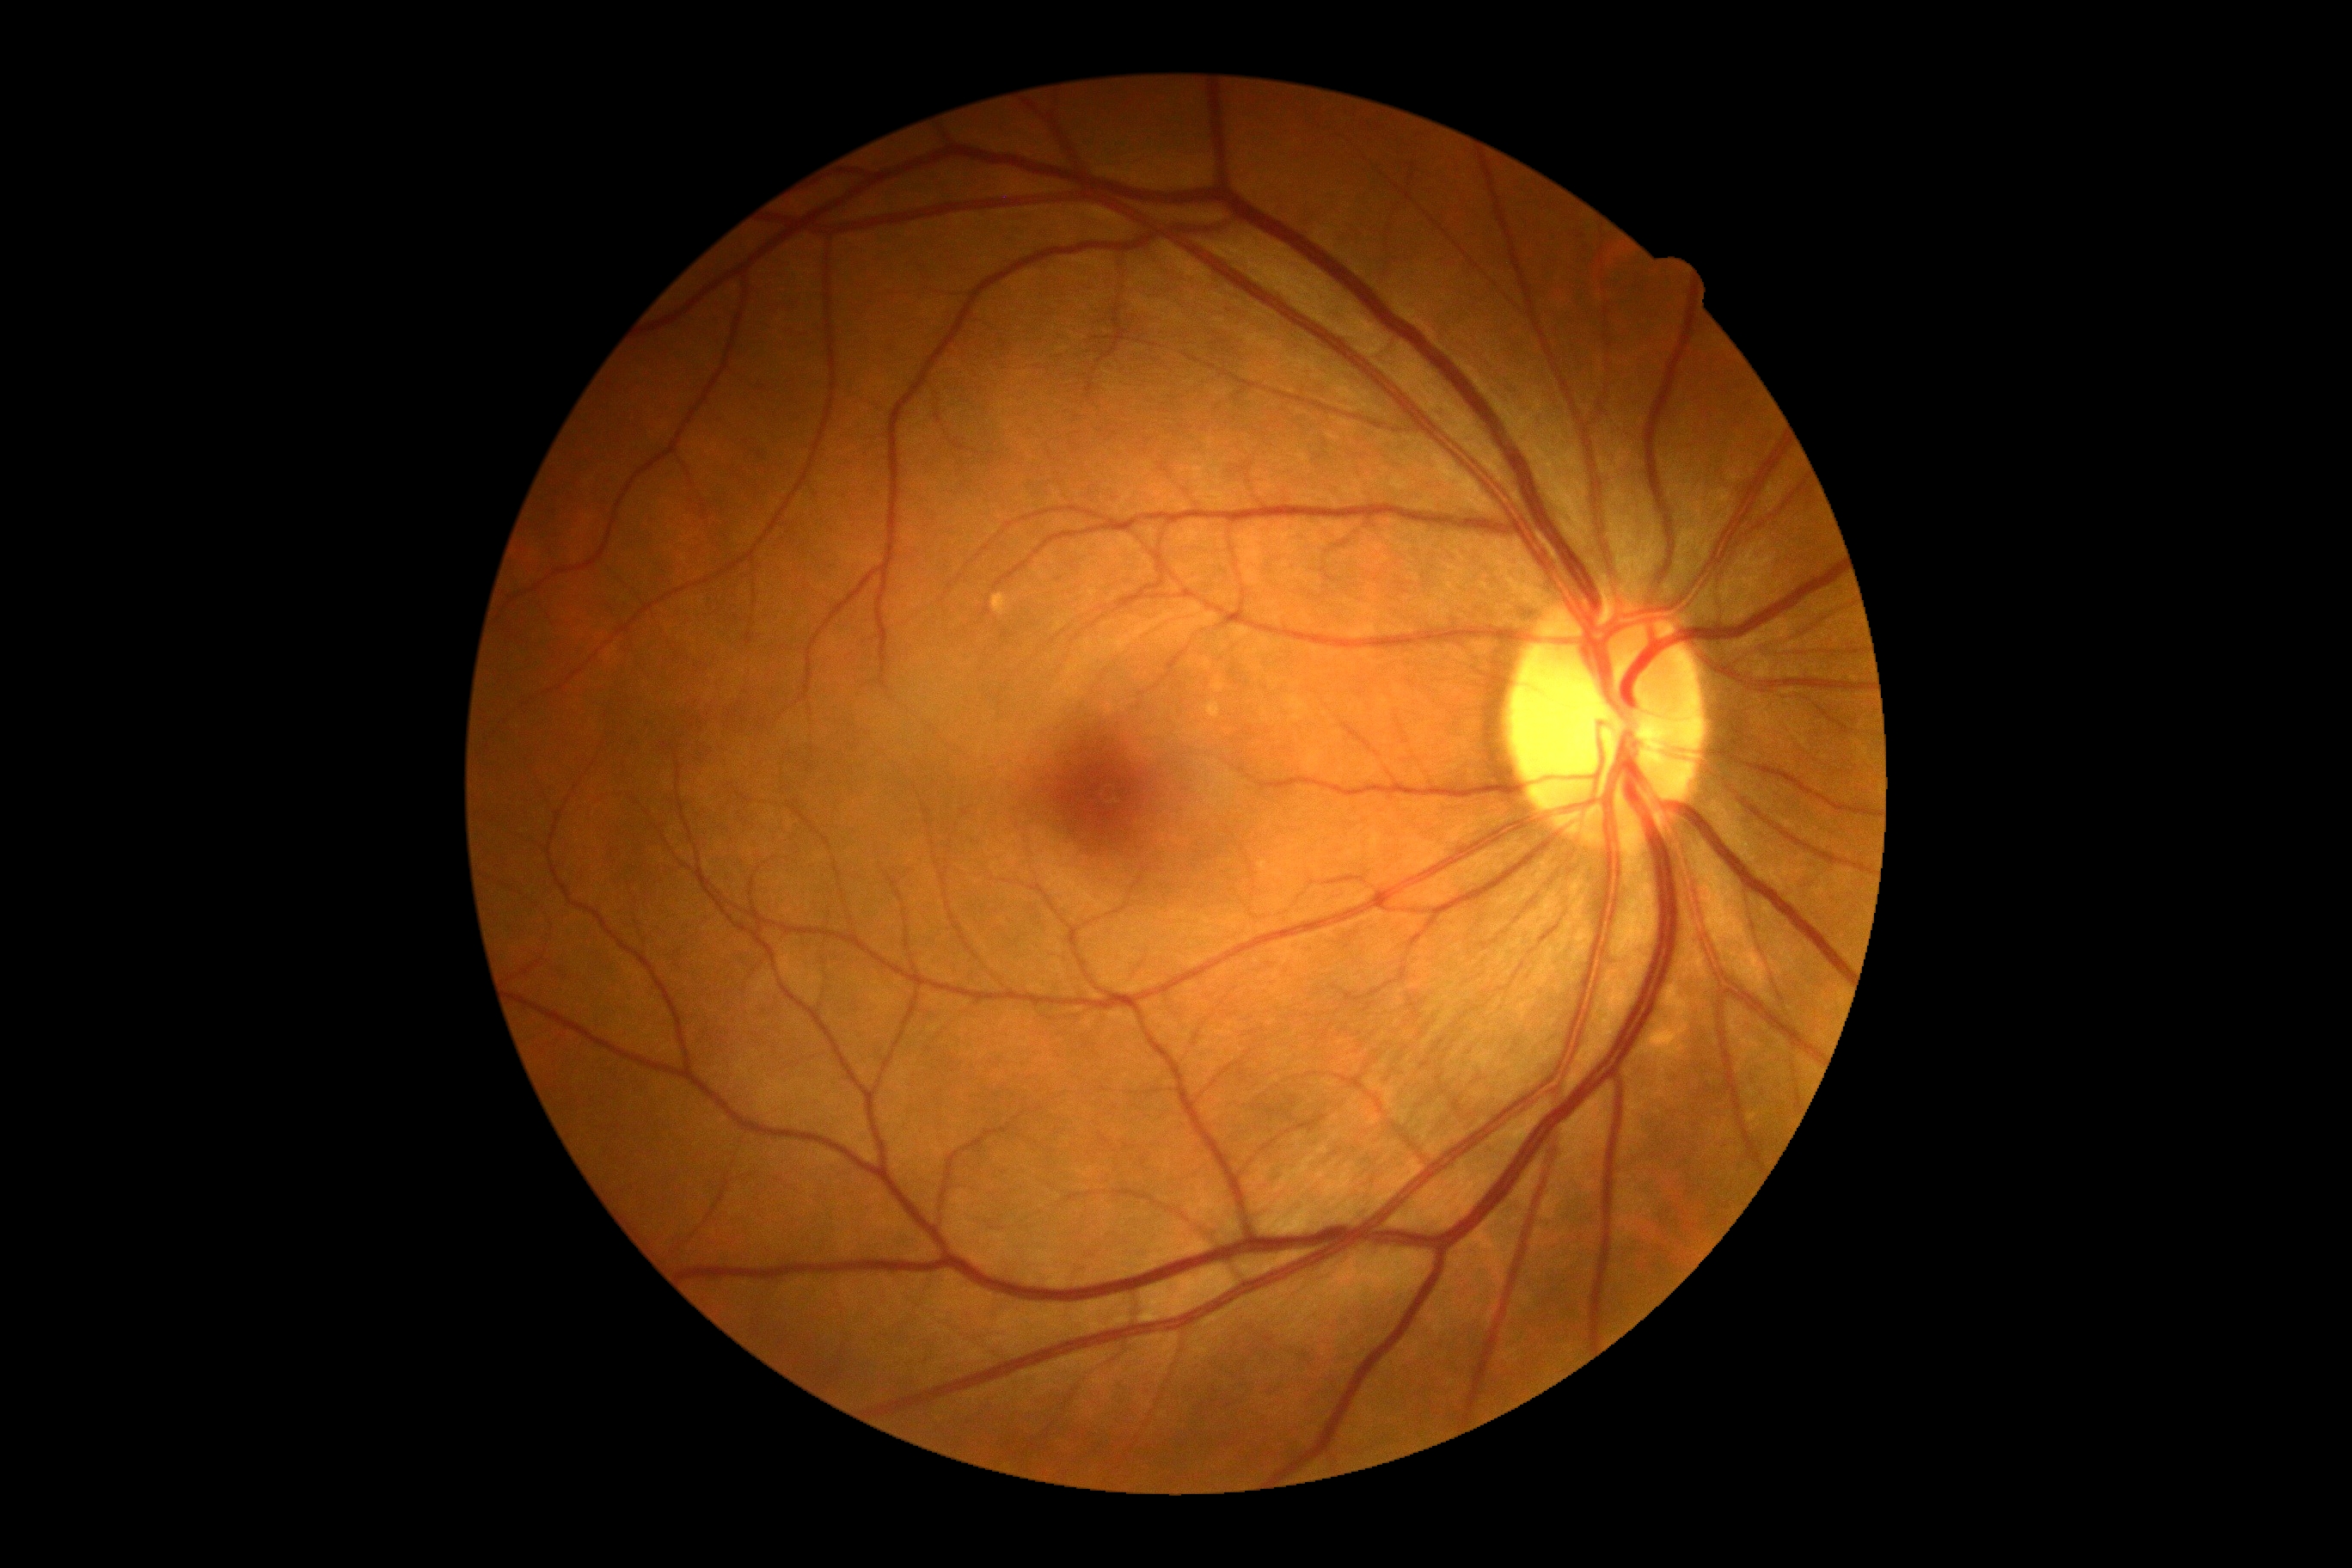 DR severity: no apparent retinopathy (grade 0).